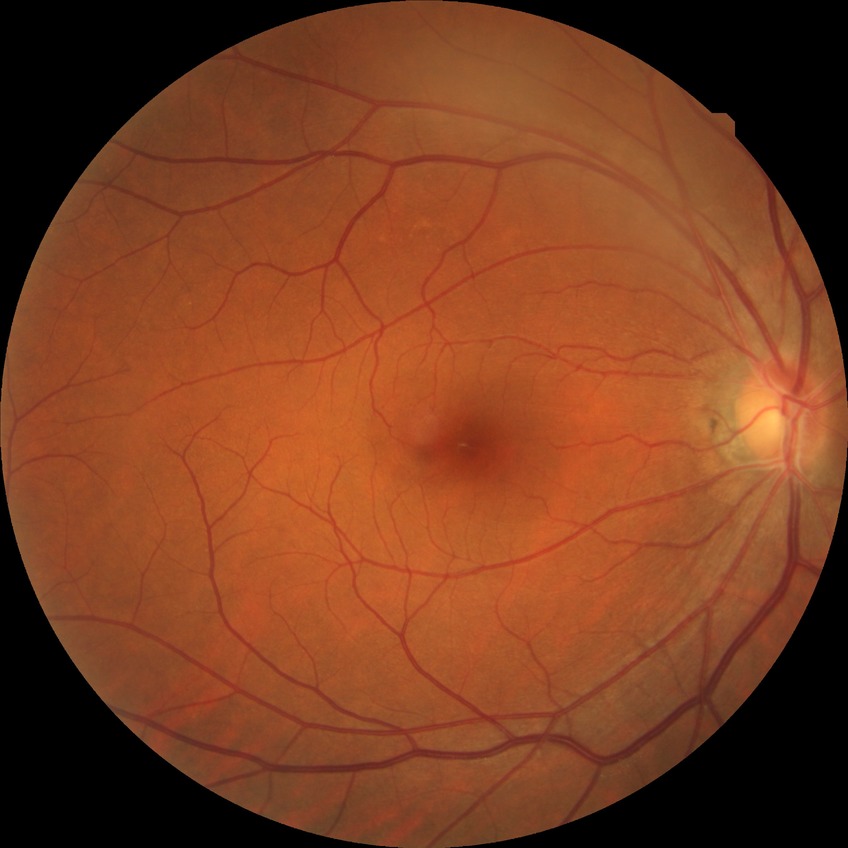 Diabetic retinopathy (DR): no diabetic retinopathy (NDR).